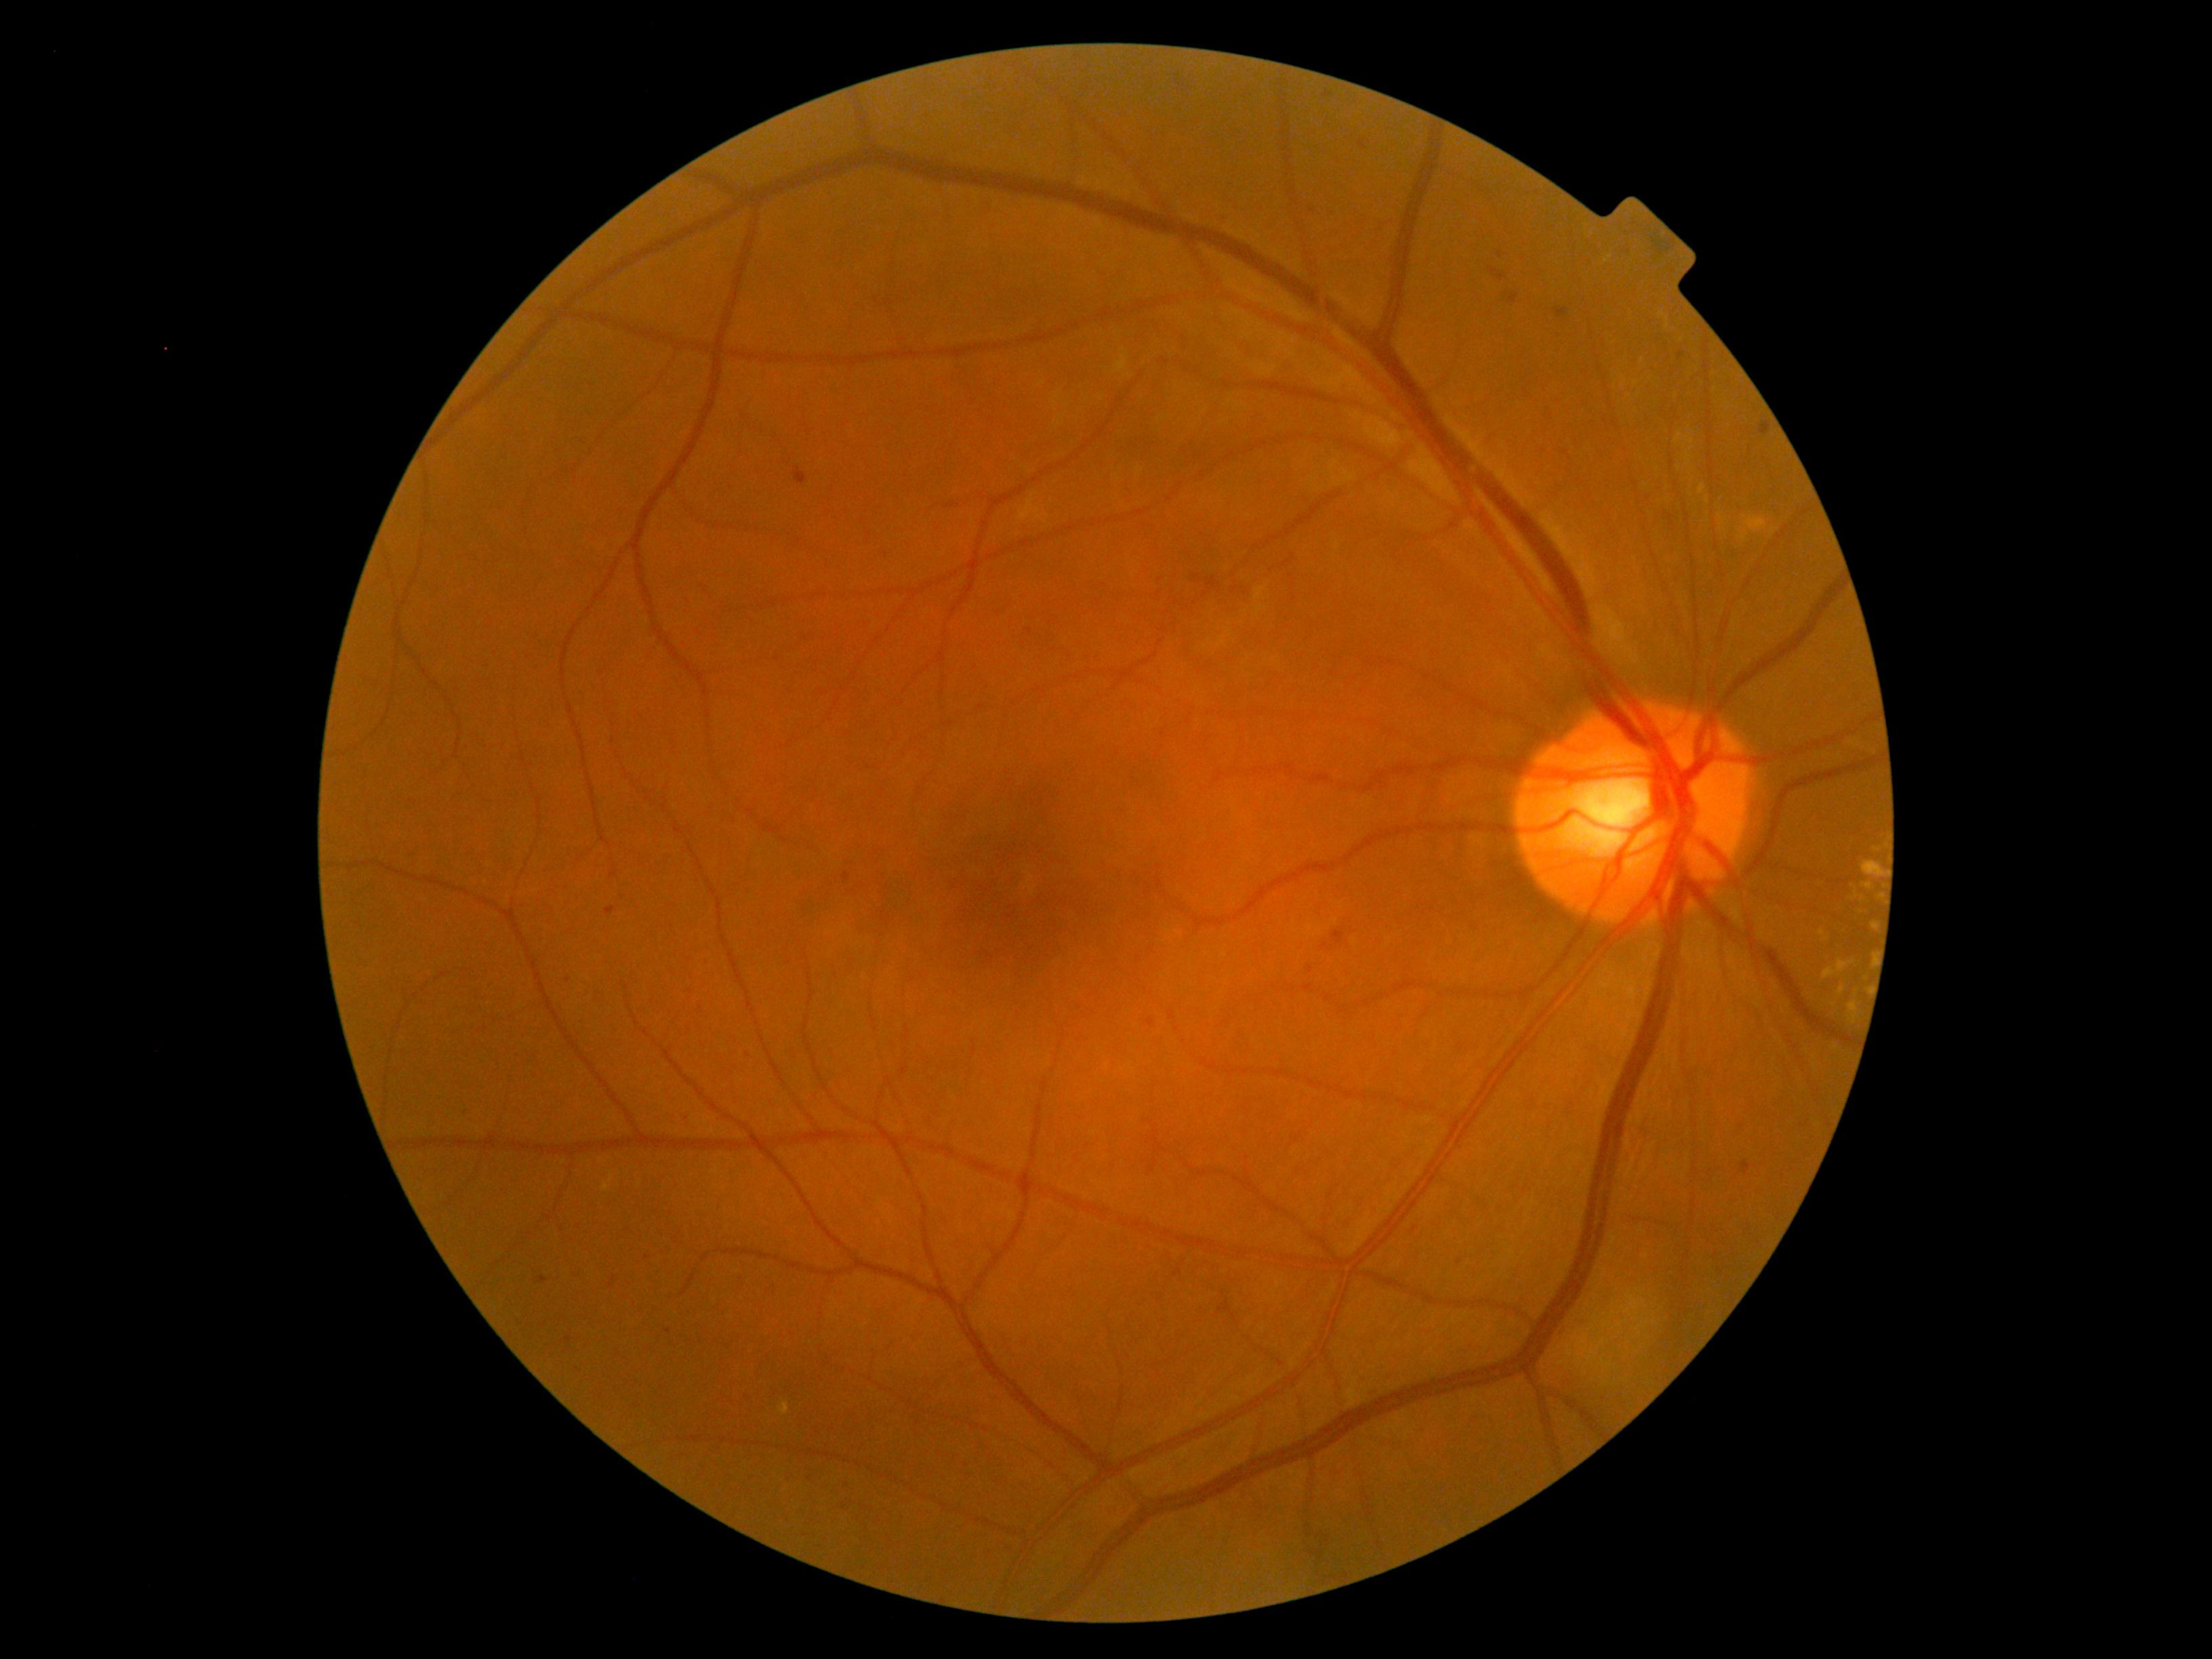 DR class=non-proliferative diabetic retinopathy; retinopathy grade=2 (moderate NPDR) — more than just microaneurysms but less than severe NPDR.